Captured without pupil dilation. Retinal fundus photograph: 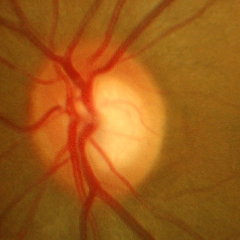 Assessment = early glaucomatous optic neuropathy. (Criteria: glaucomatous retinal nerve fiber layer defects on red-free fundus photography without visual field defects.)